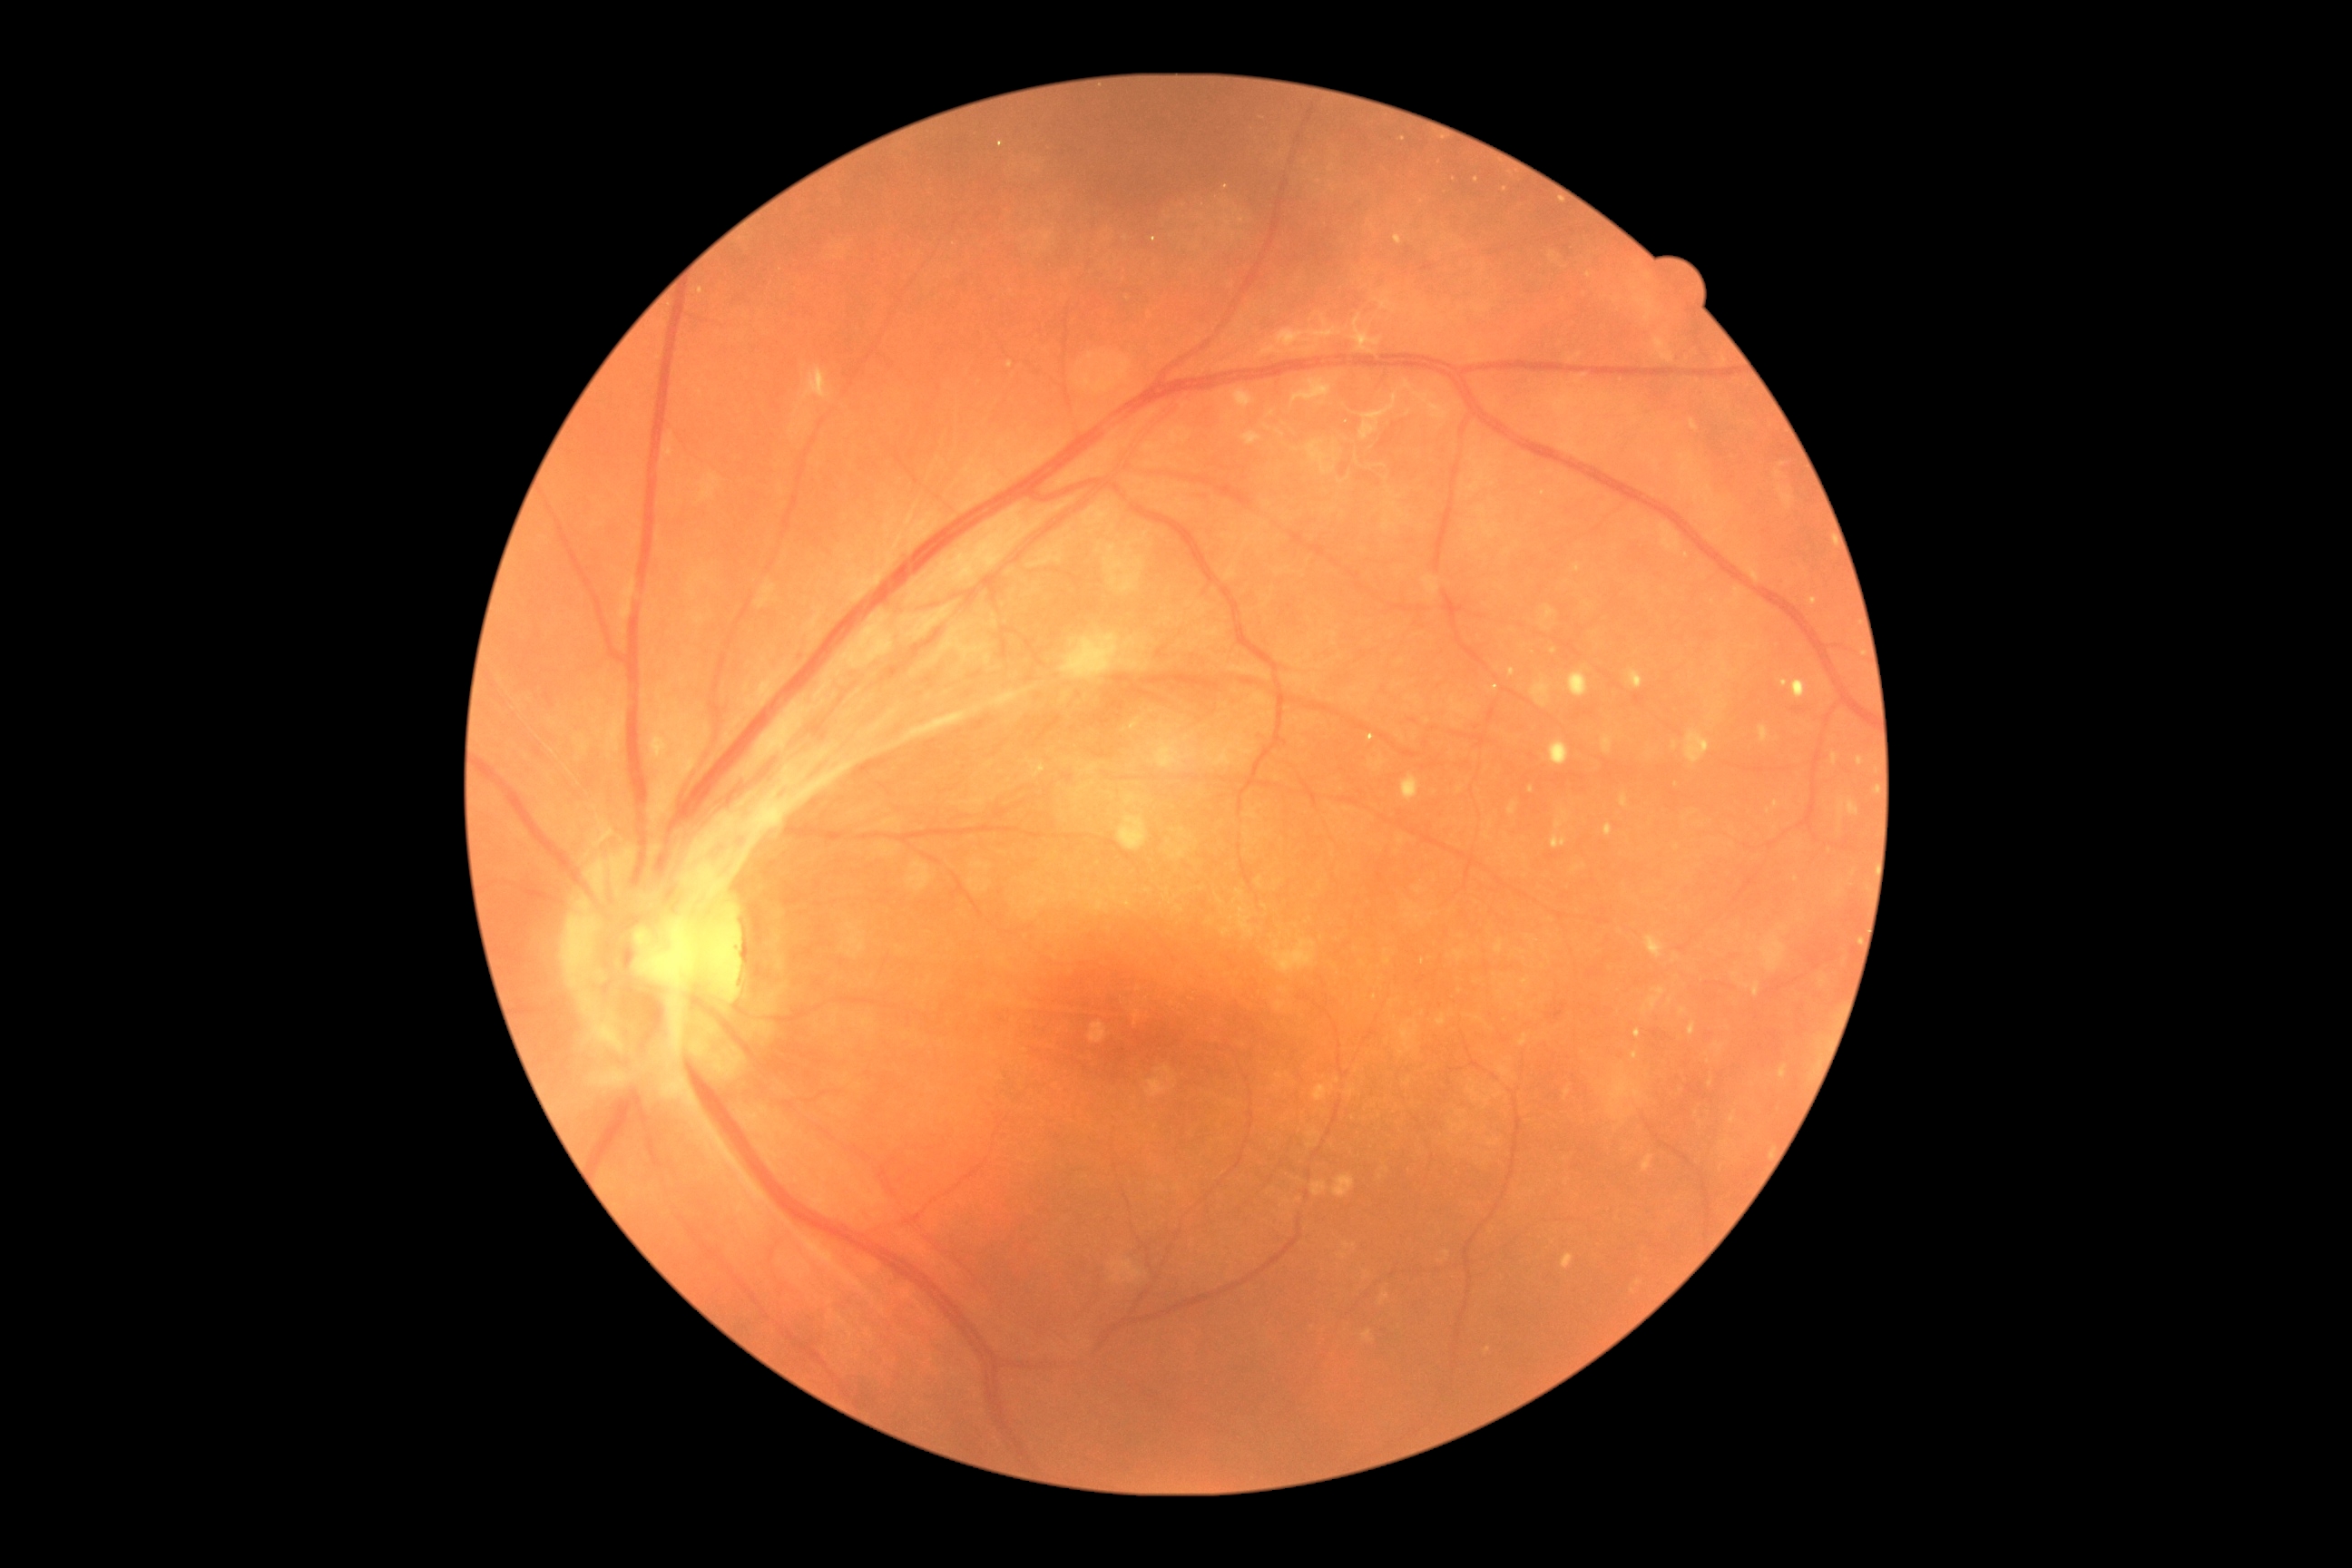
{"dr_grade":4,"lesions":{"se":null,"ma":null,"ex":null,"he":[[1634,694,1647,707],[1547,1003,1567,1021]]}}